Nonmydriatic fundus photograph; NIDEK AFC-230 — 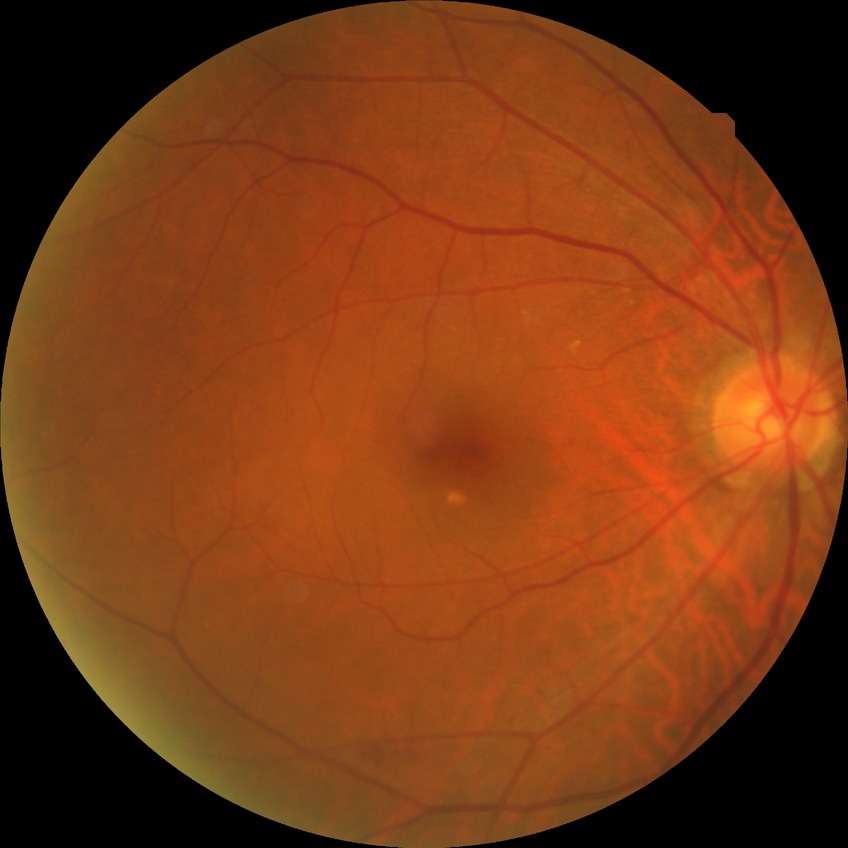

Modified Davis grade is SDR.